Camera: NIDEK AFC-230, 45-degree field of view, 848 x 848 pixels
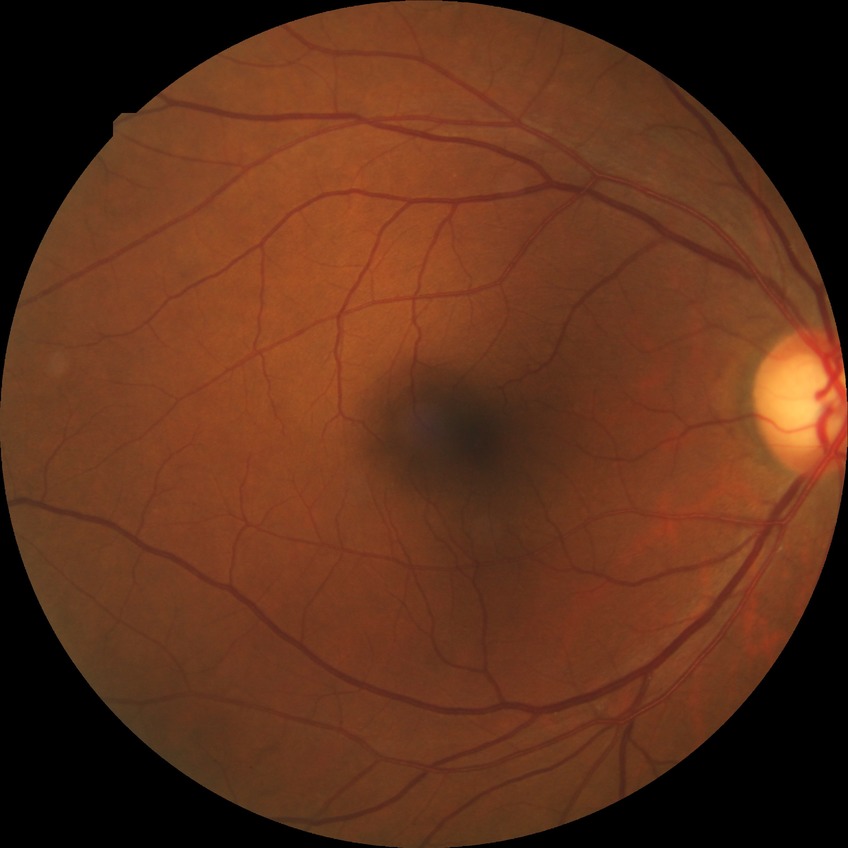

Diabetic retinopathy grade is no diabetic retinopathy.